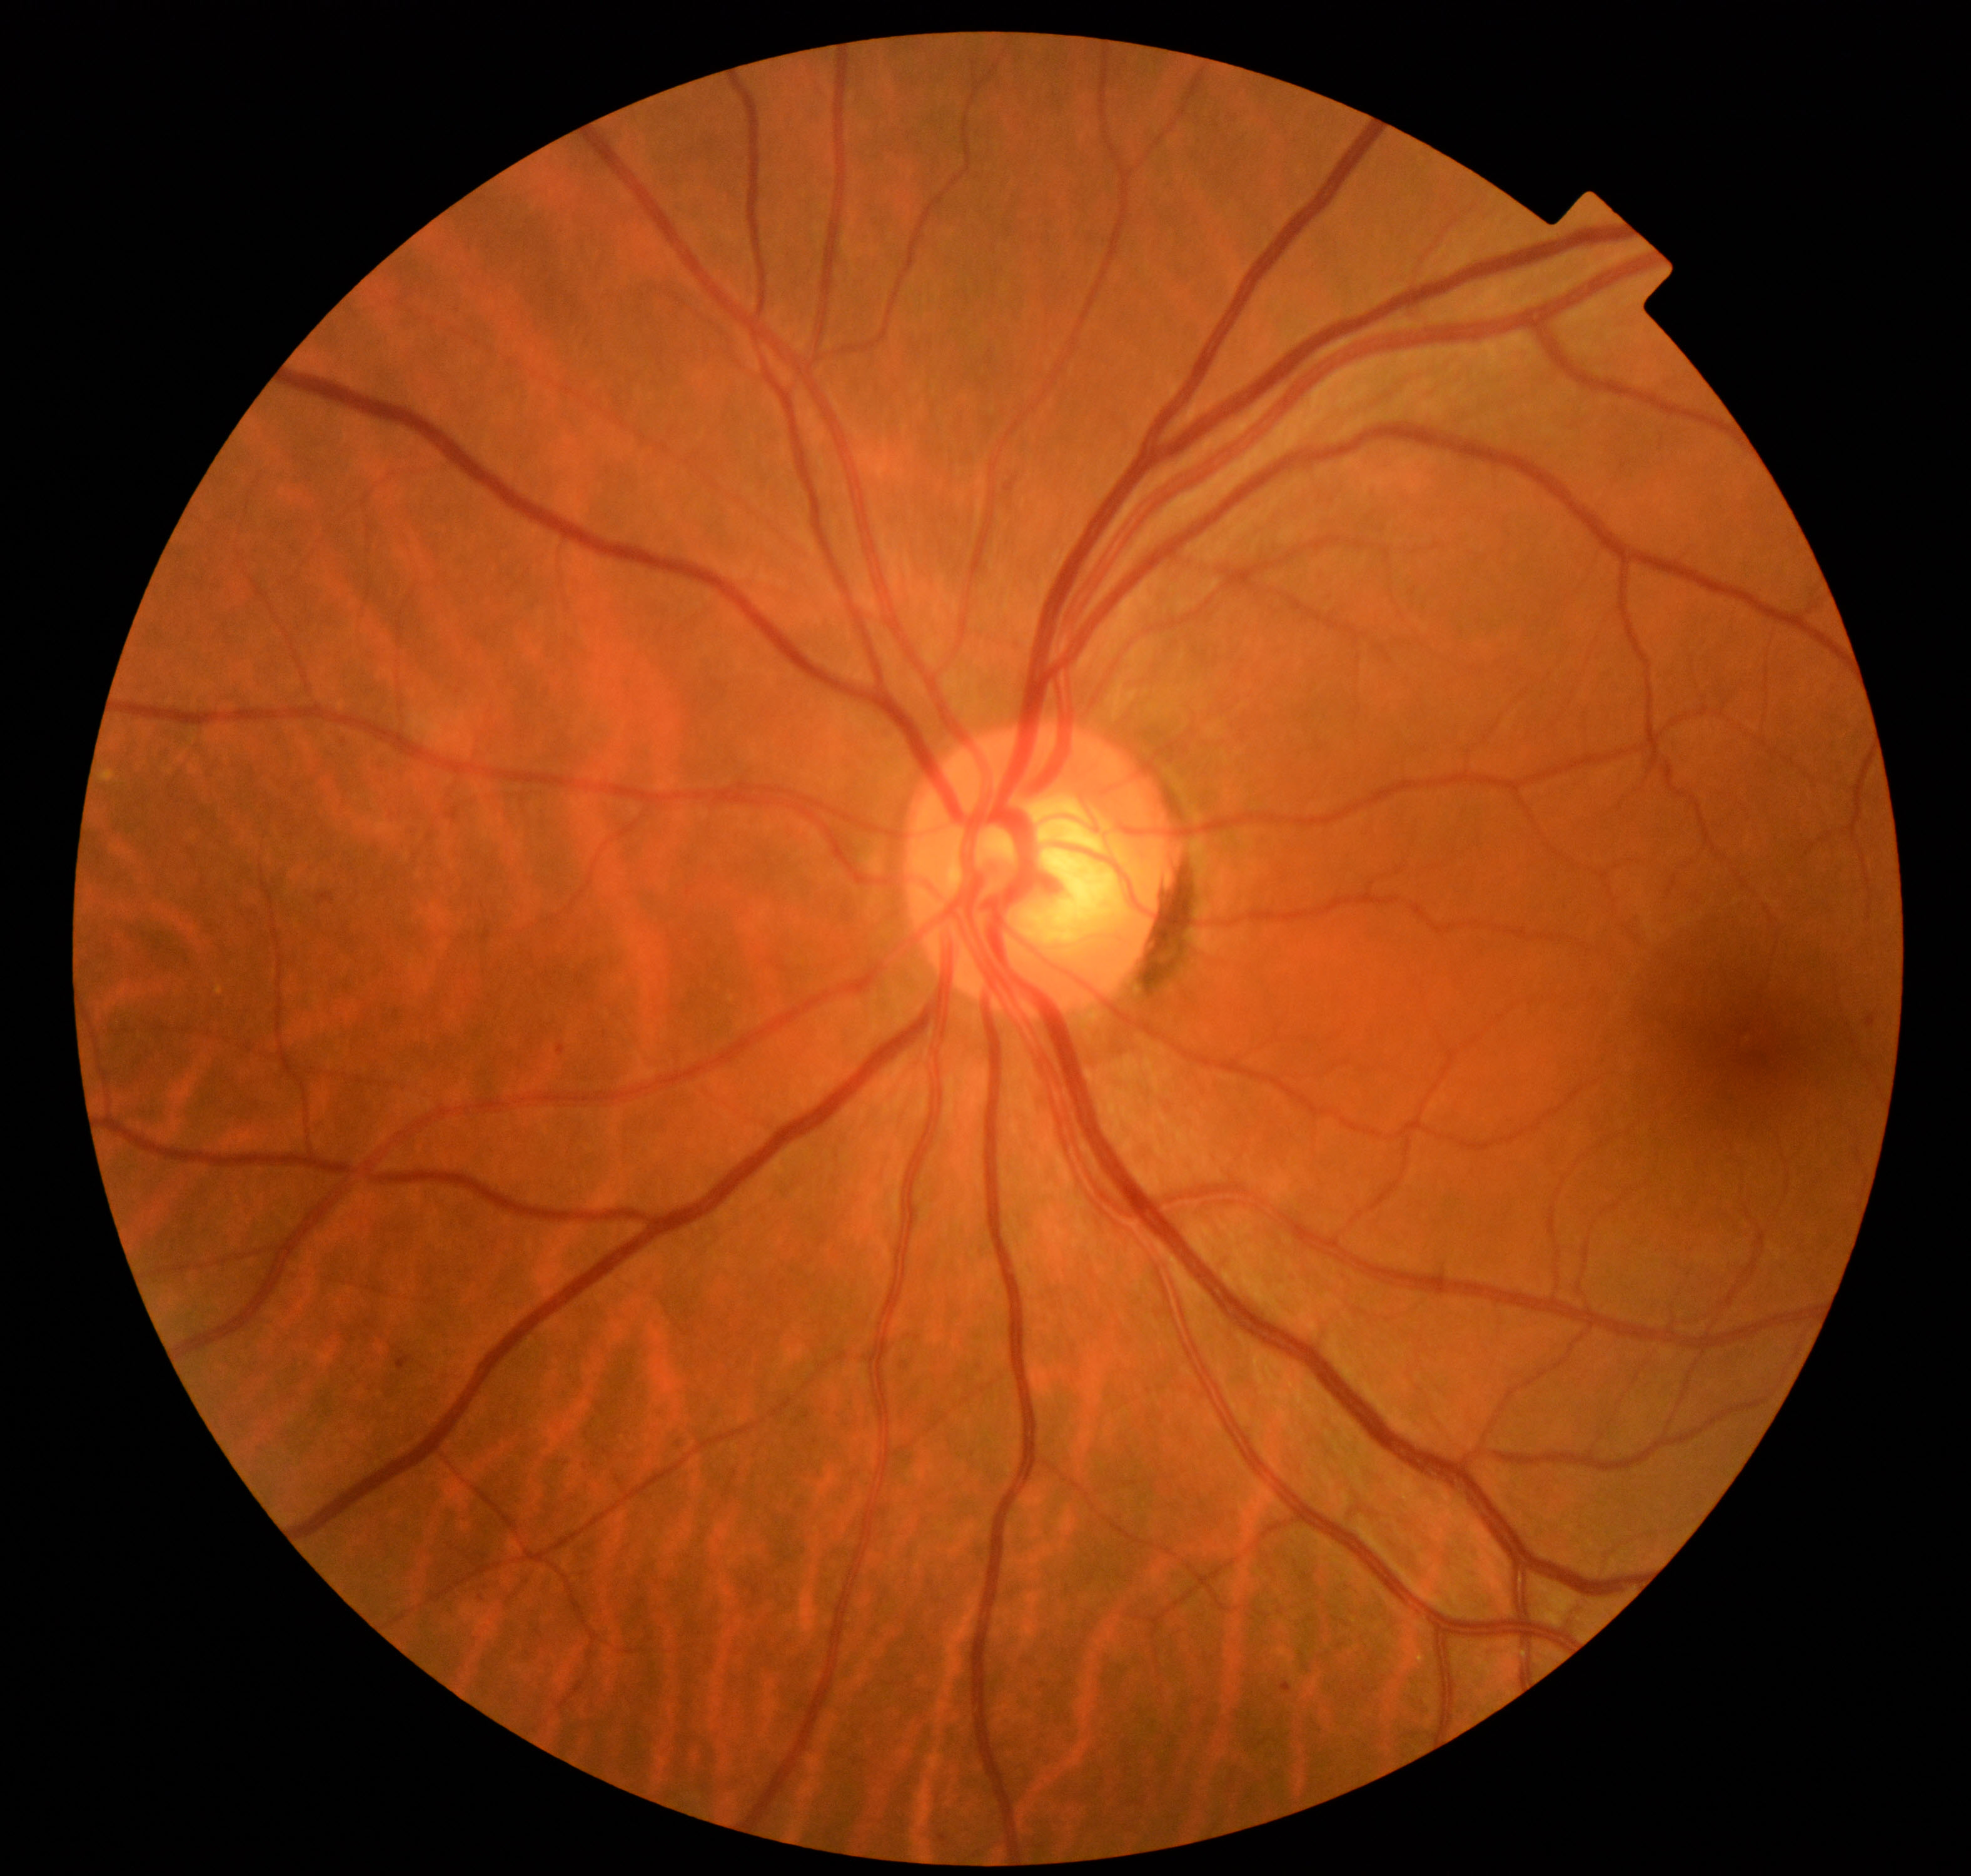
Diagnosis: mild non-proliferative diabetic retinopathy.